Image size 412x310:
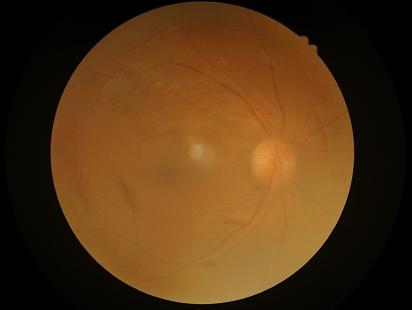
{
  "illumination": "uneven",
  "clarity": "reduced",
  "contrast": "low",
  "overall_quality": "low"
}